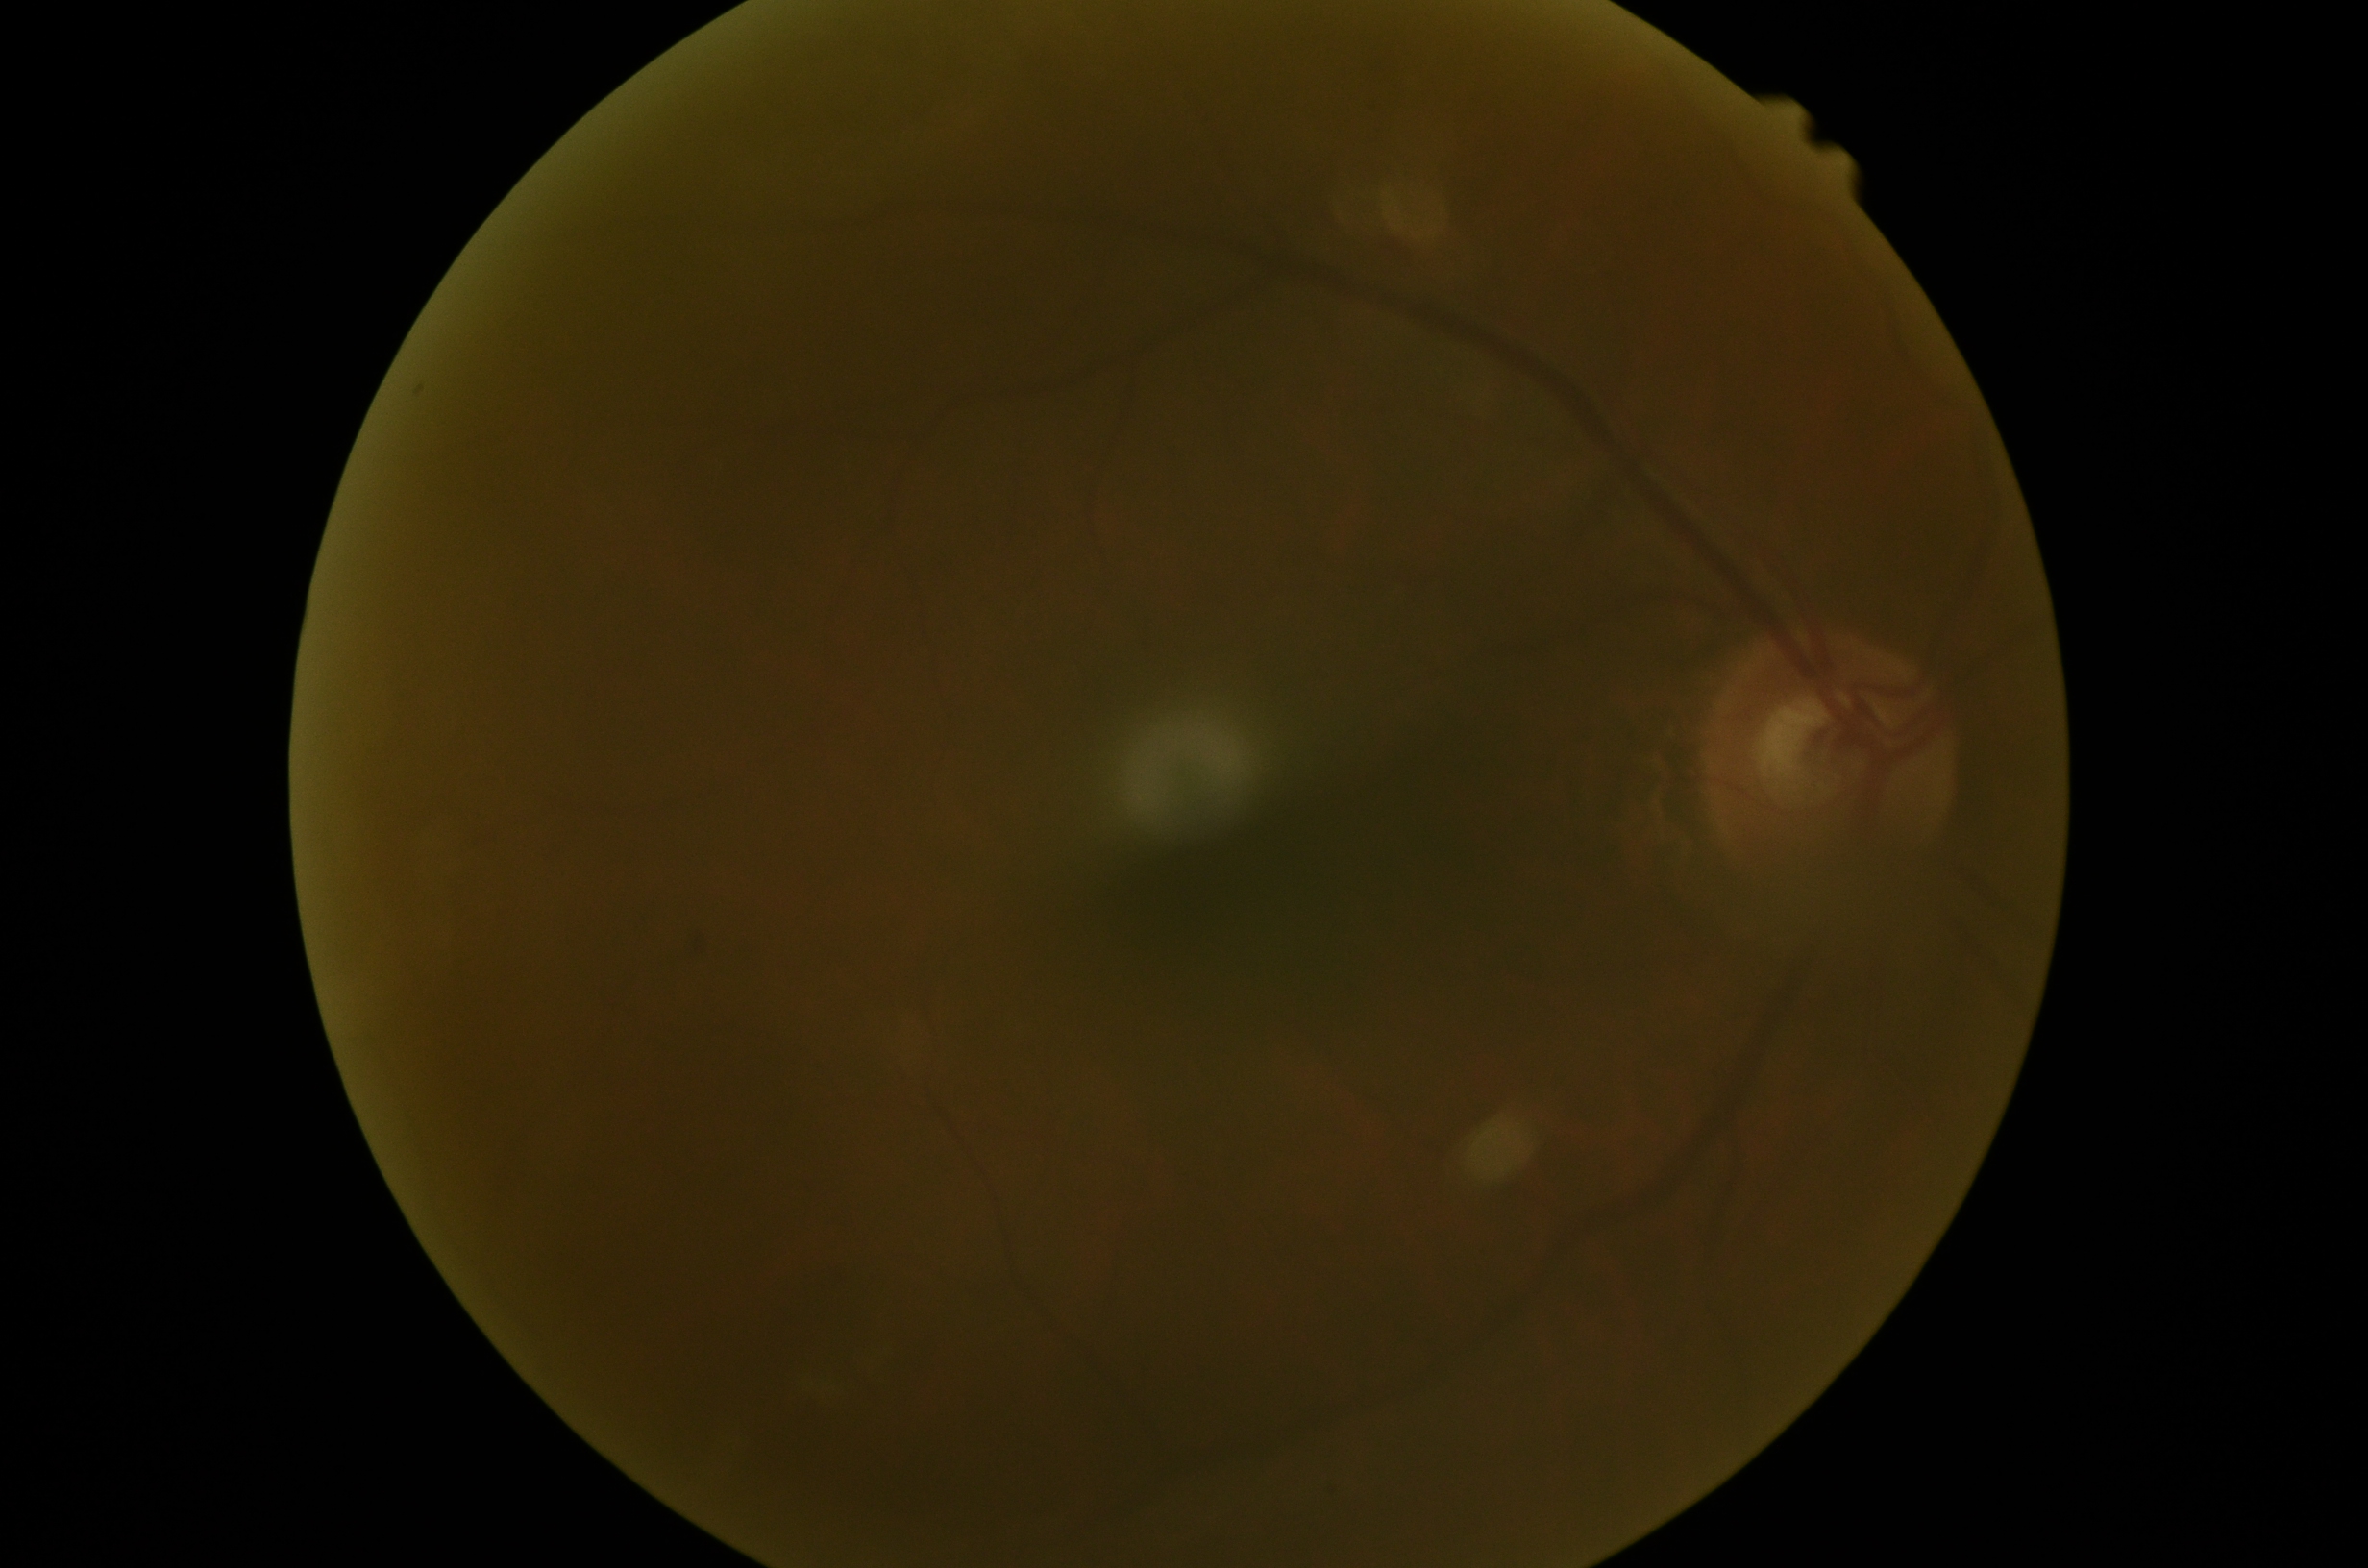

Diabetic retinopathy (DR): grade 1.